Wide-field fundus photograph from neonatal ROP screening · image size 1240x1240 · camera: Phoenix ICON (100° FOV): 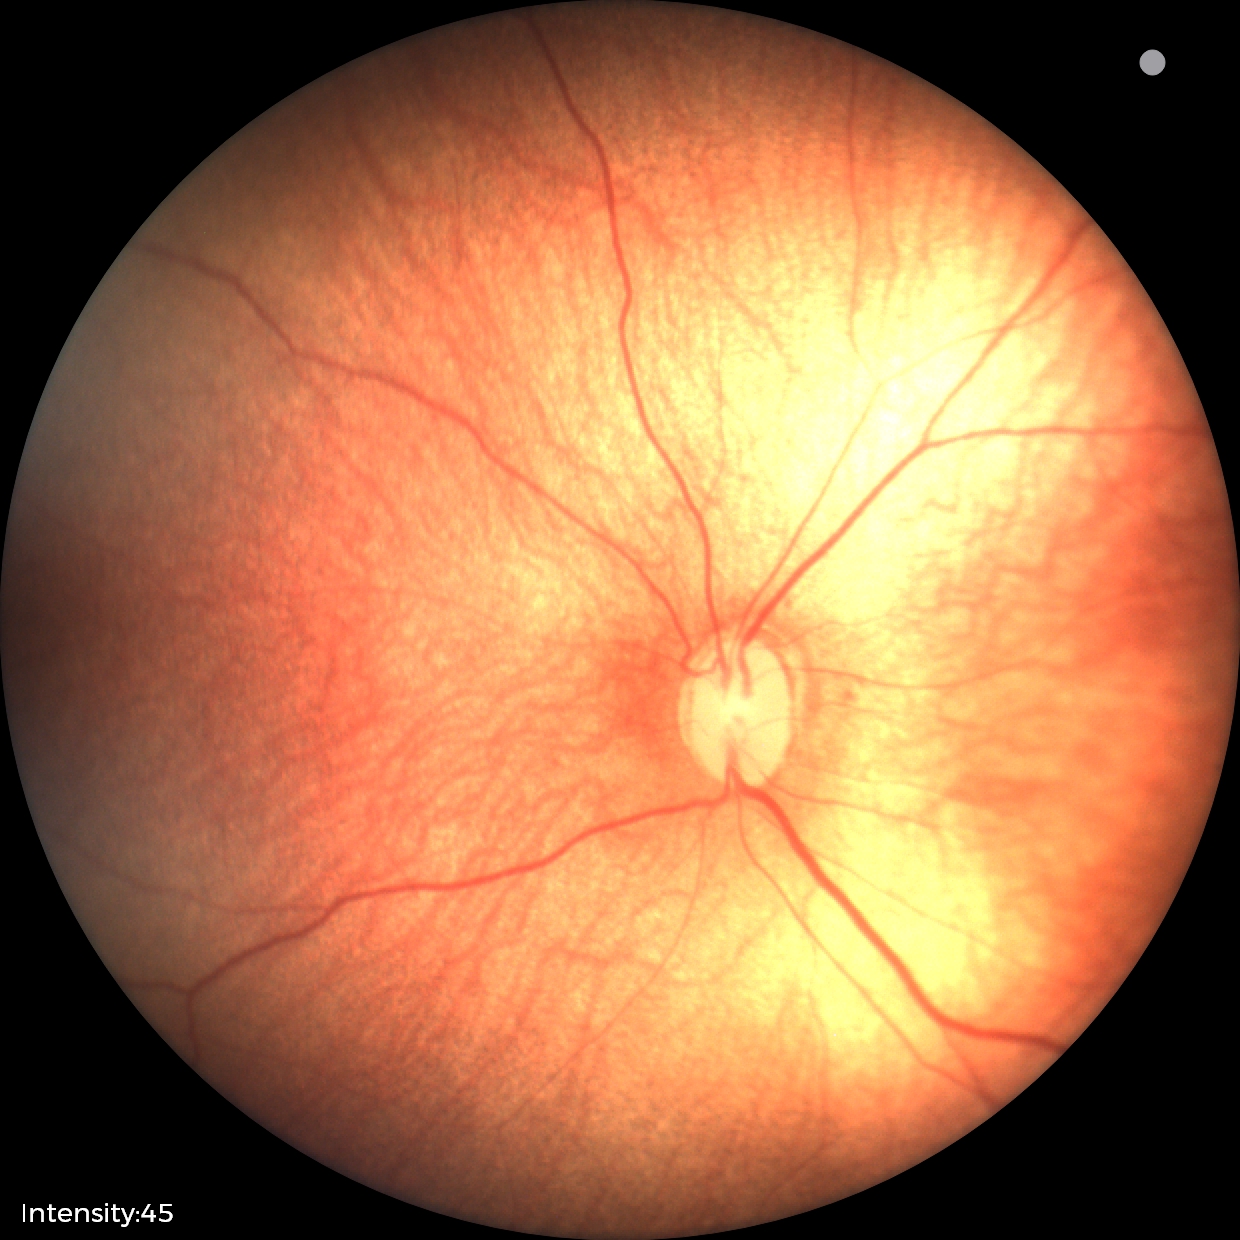

From an examination with diagnosis of retinopathy of prematurity (ROP) stage 1. Plus disease absent.